Disc-centered field
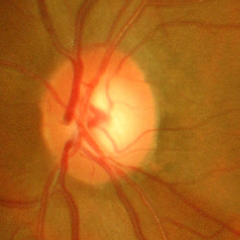

Severe glaucomatous damage.
Diagnostic criteria: near-total cupping of the optic nerve head, with or without severe visual field loss within the central 10 degrees of fixation.